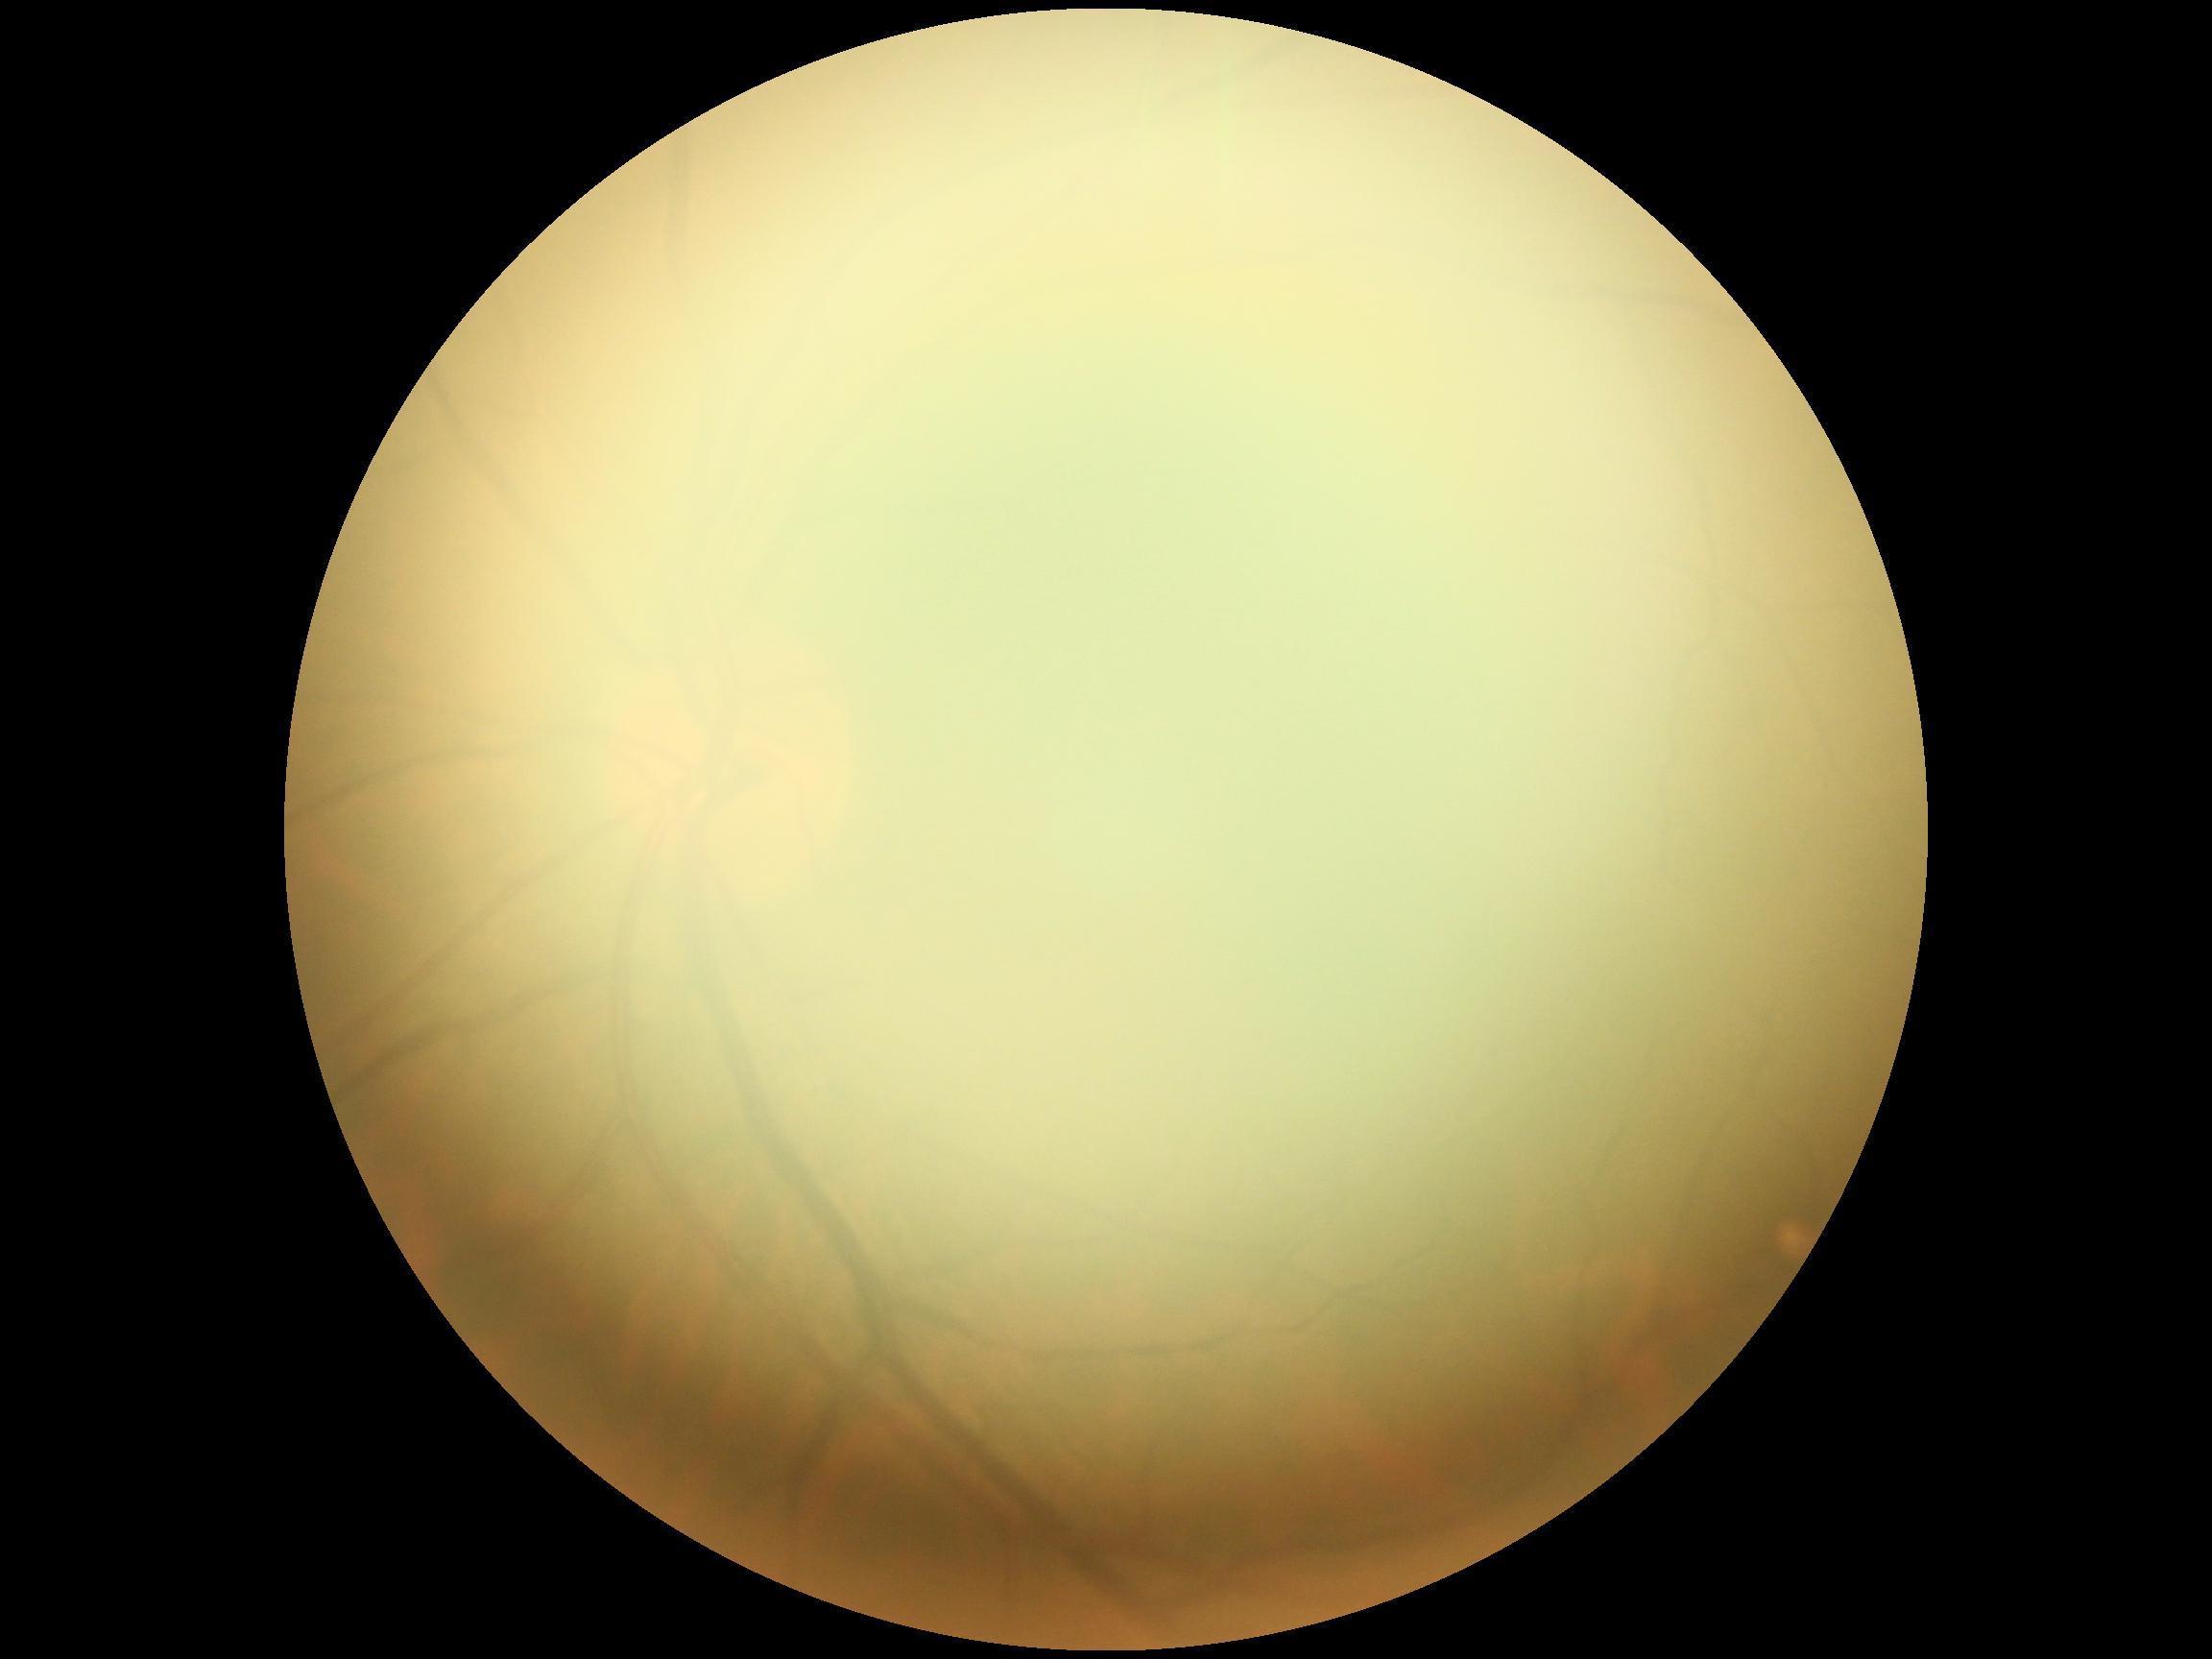

Image quality is insufficient for diabetic retinopathy assessment. DR grade is ungradable.